Optic disc region crop.
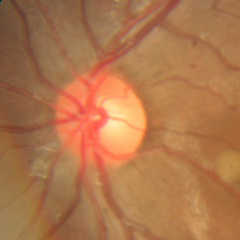

Optic disc photograph demonstrating no evidence of glaucoma.